NIDEK AFC-230, fundus photo:
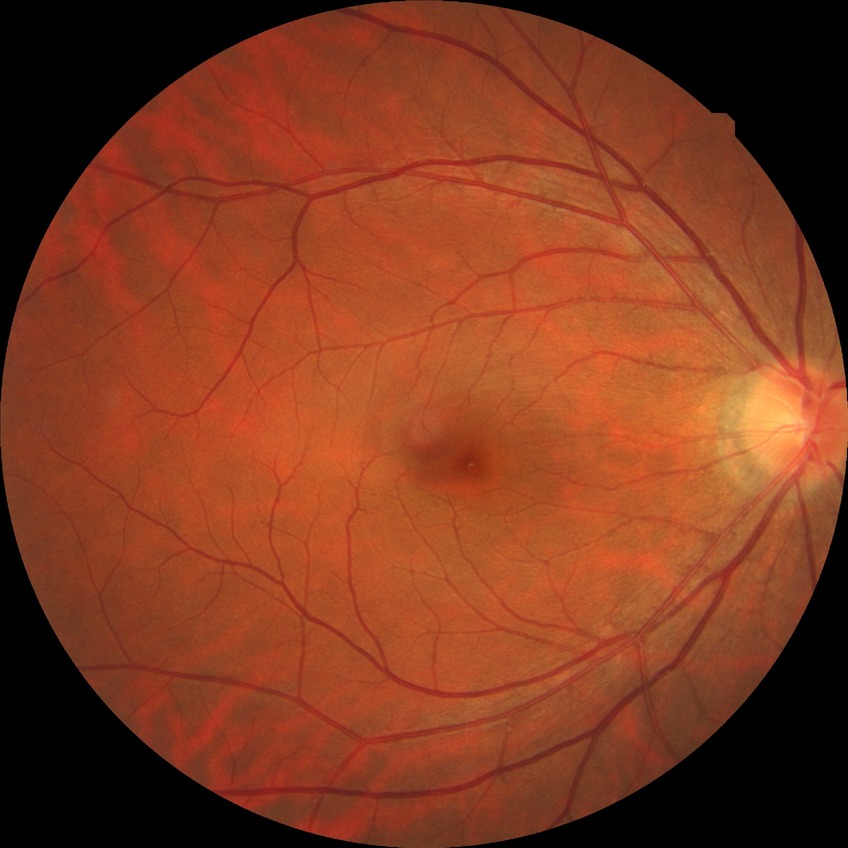

Retinopathy stage: no diabetic retinopathy.